Acquired on the Clarity RetCam 3 · wide-field contact fundus photograph of an infant · image size 640x480: 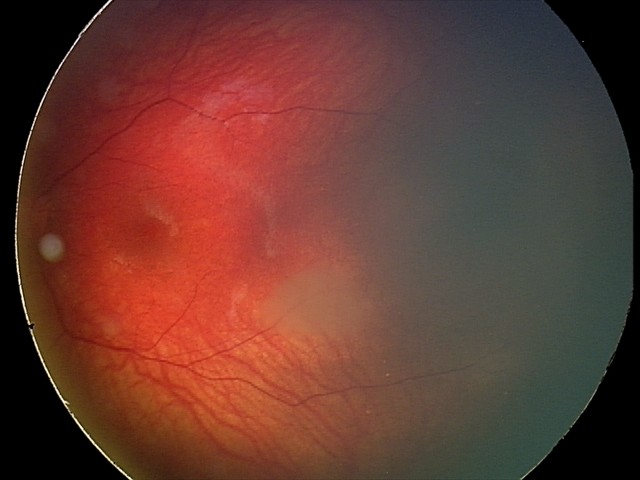

Screening examination consistent with retinal astrocytic hamartoma.